2212 x 1659 pixels. 45° FOV. Color fundus photograph:
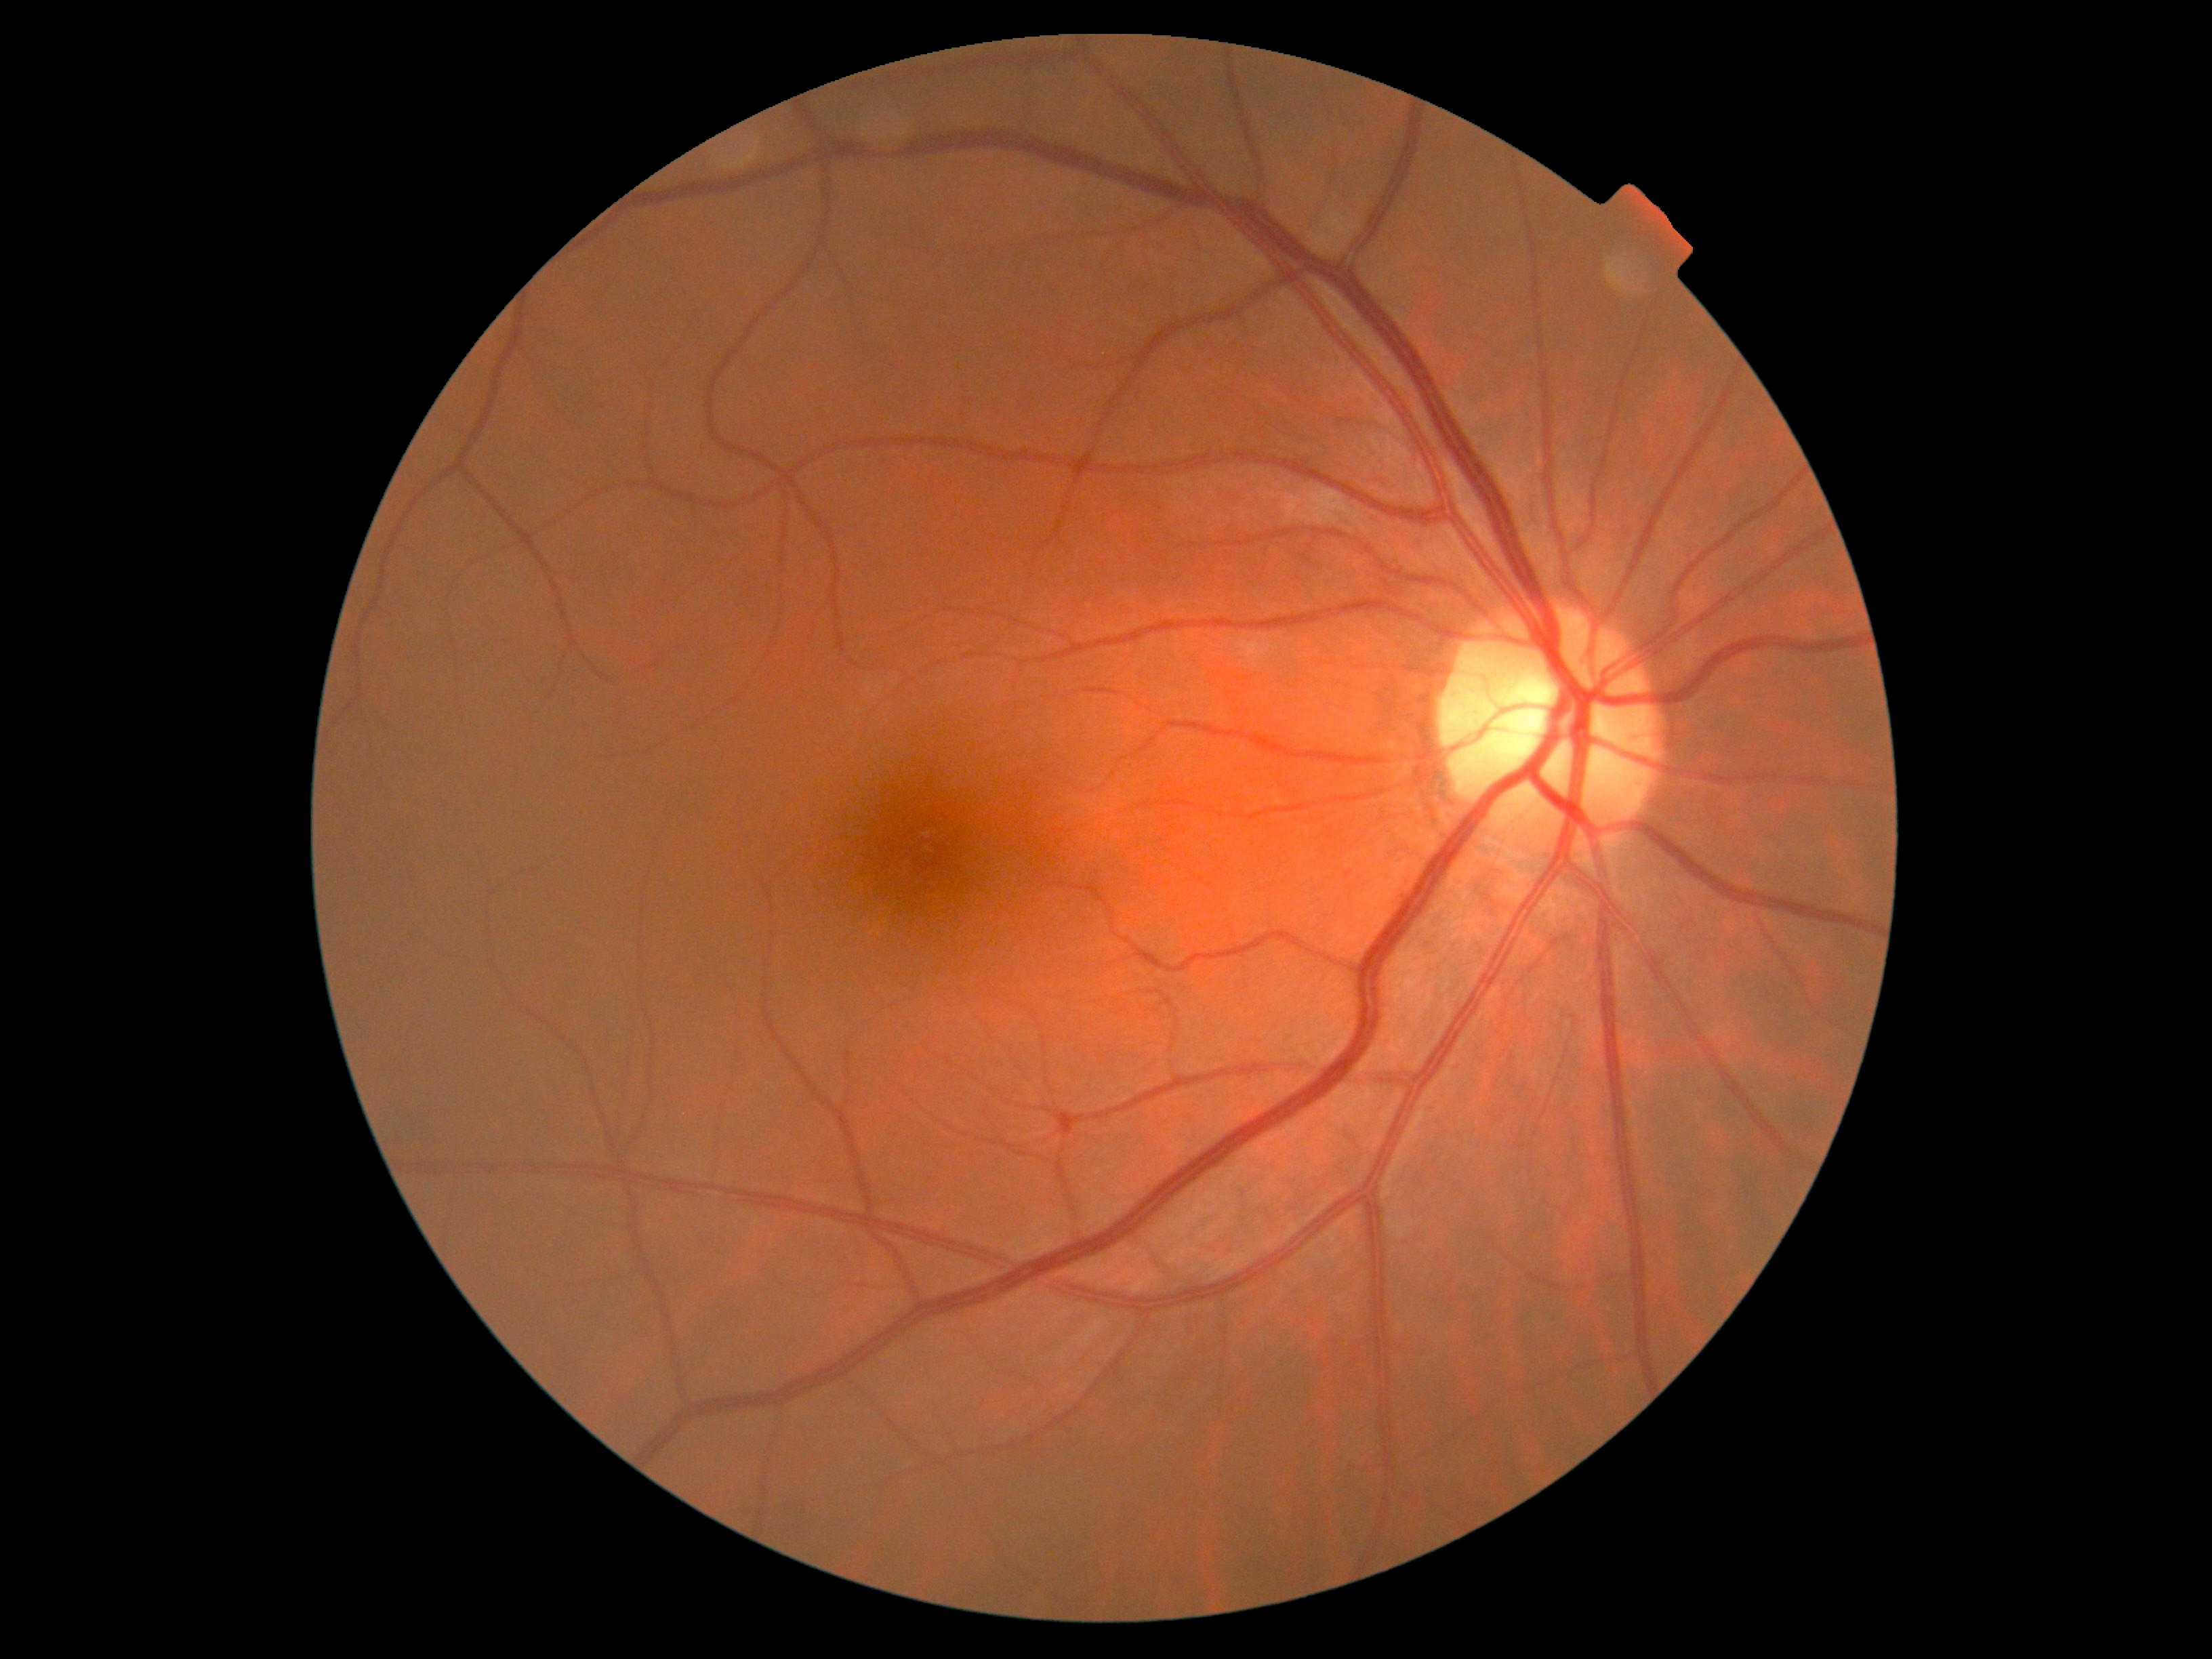
No apparent diabetic retinopathy. Diabetic retinopathy (DR) is 0.